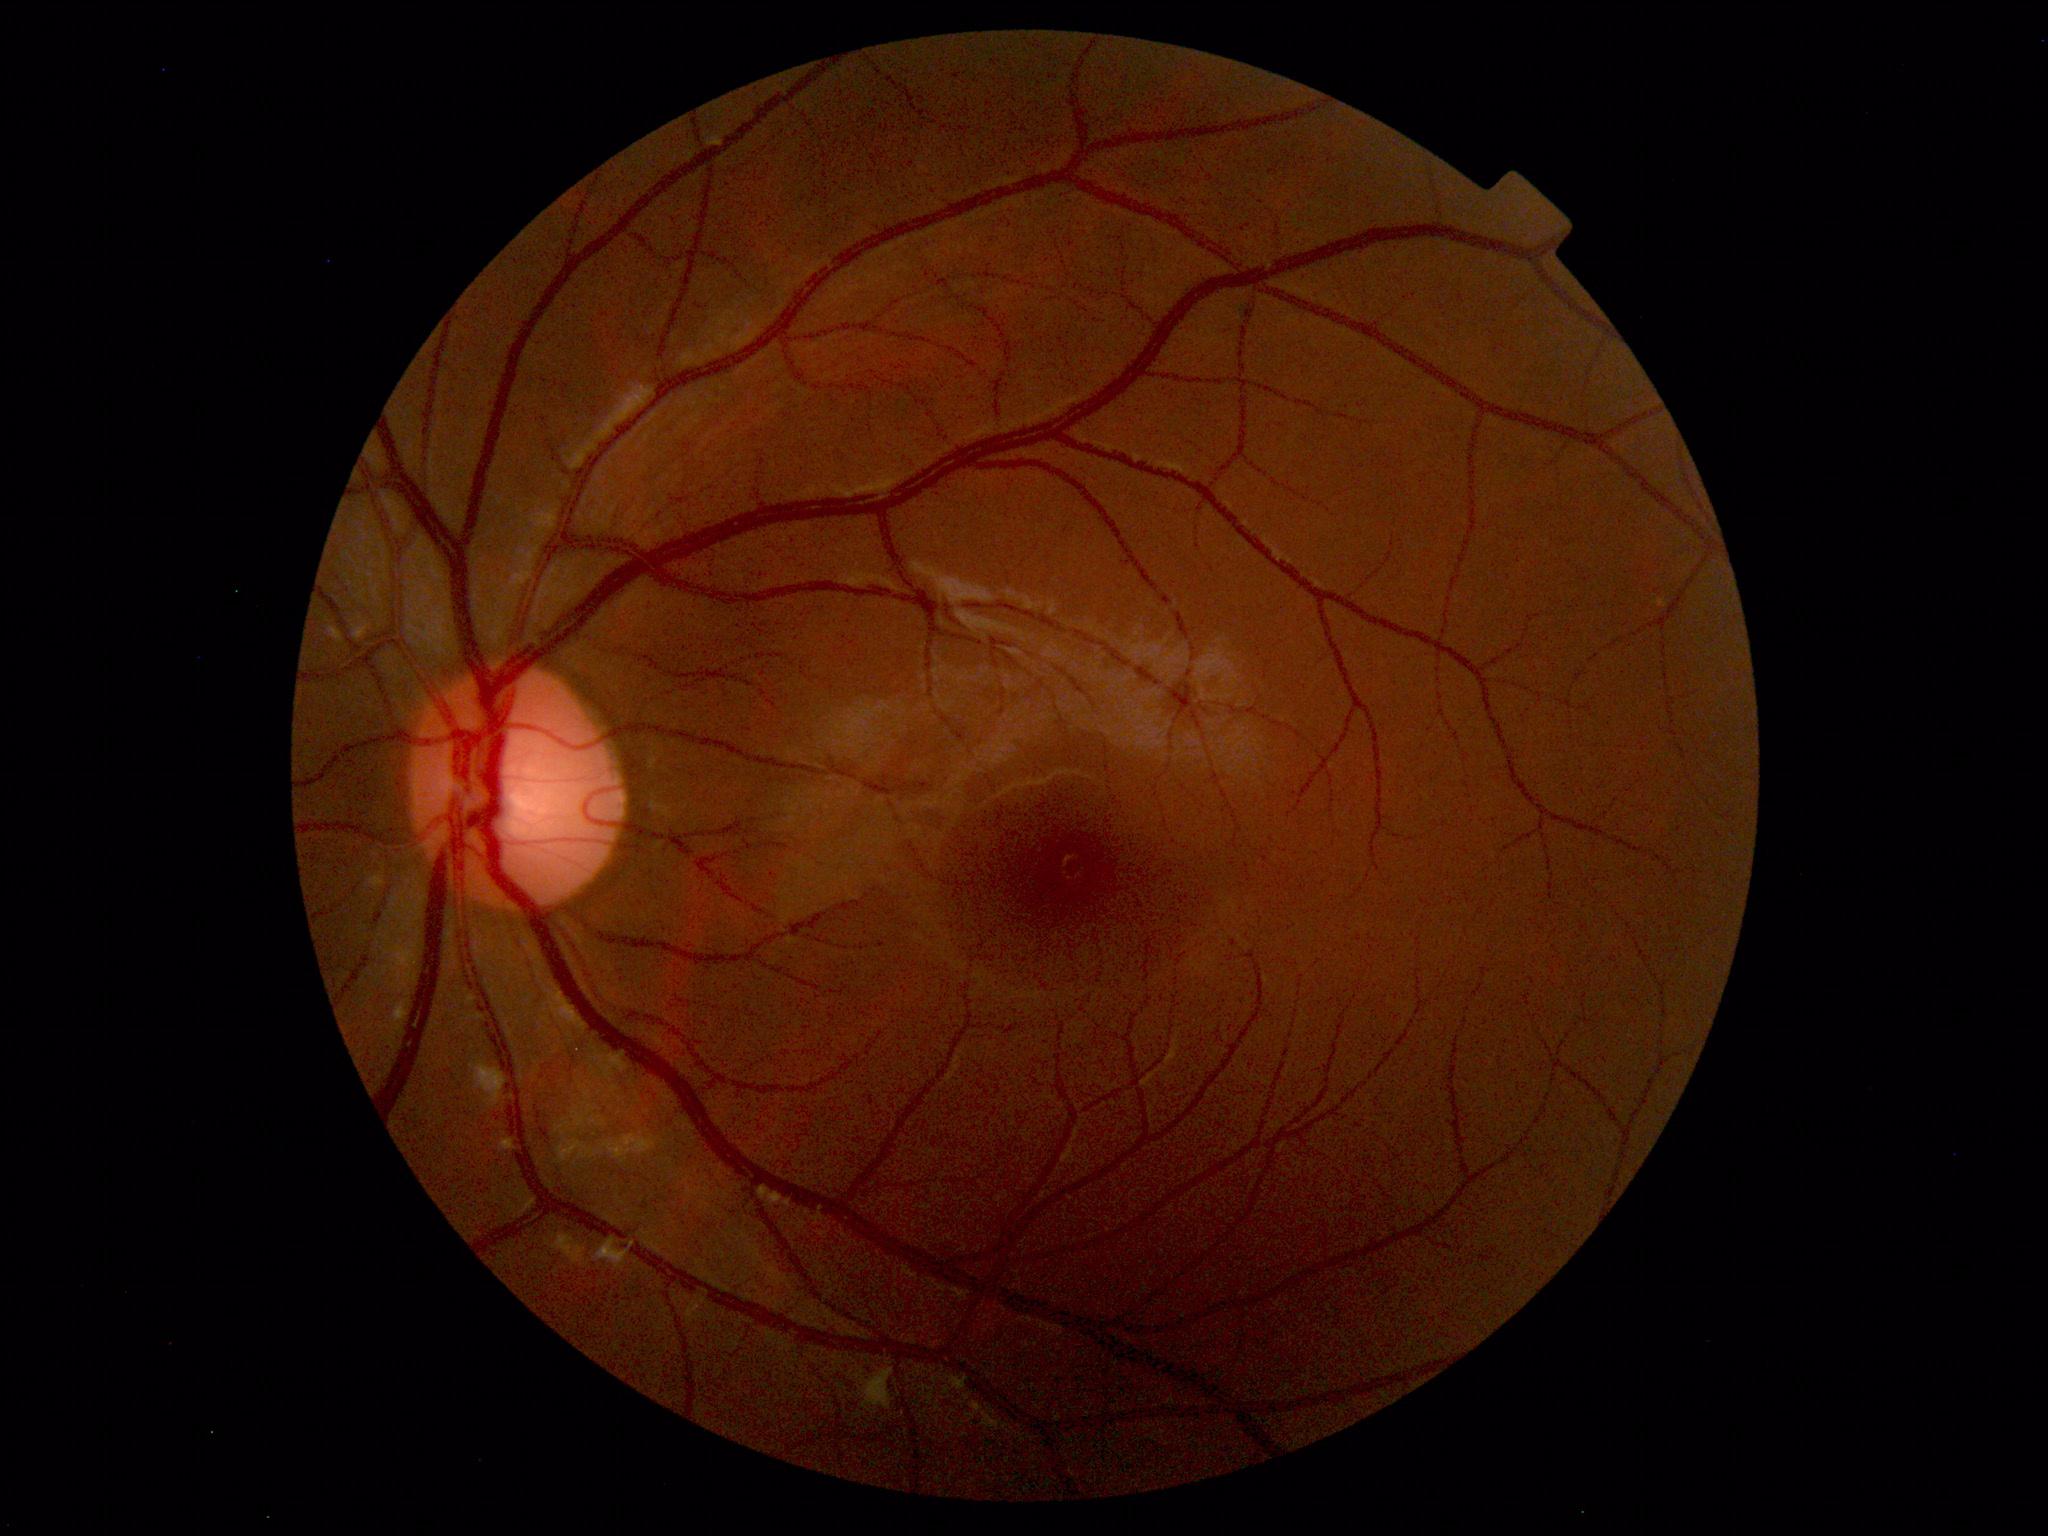 Normal fundus. No pathology identified.